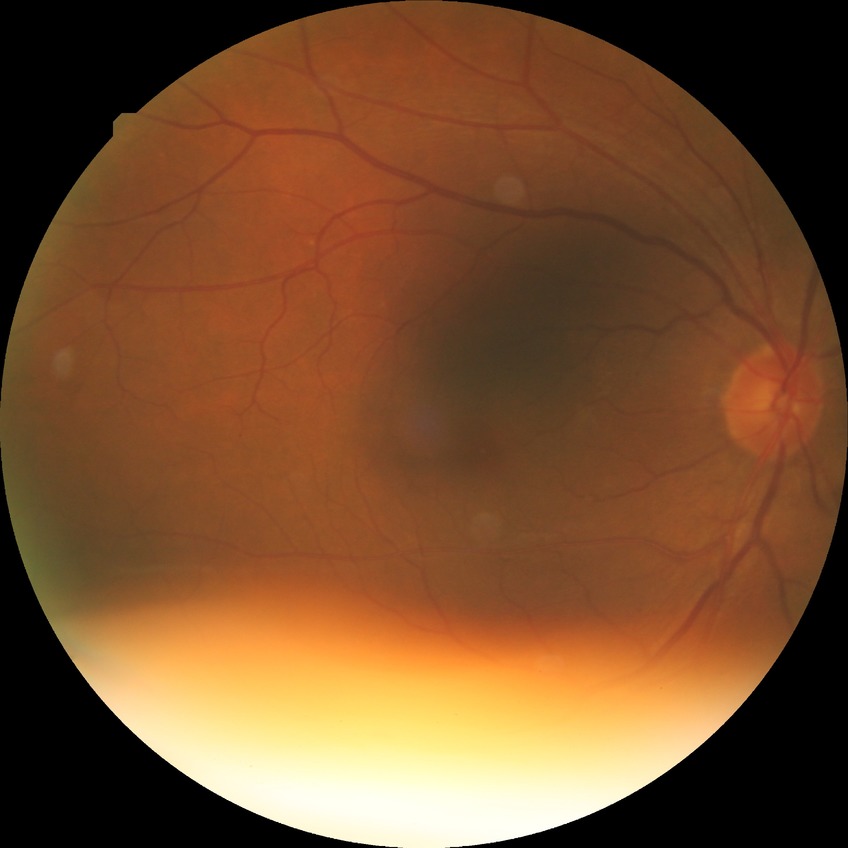

diabetic retinopathy stage=no diabetic retinopathy.